Retinal fundus photograph, 1380 by 1382 pixels
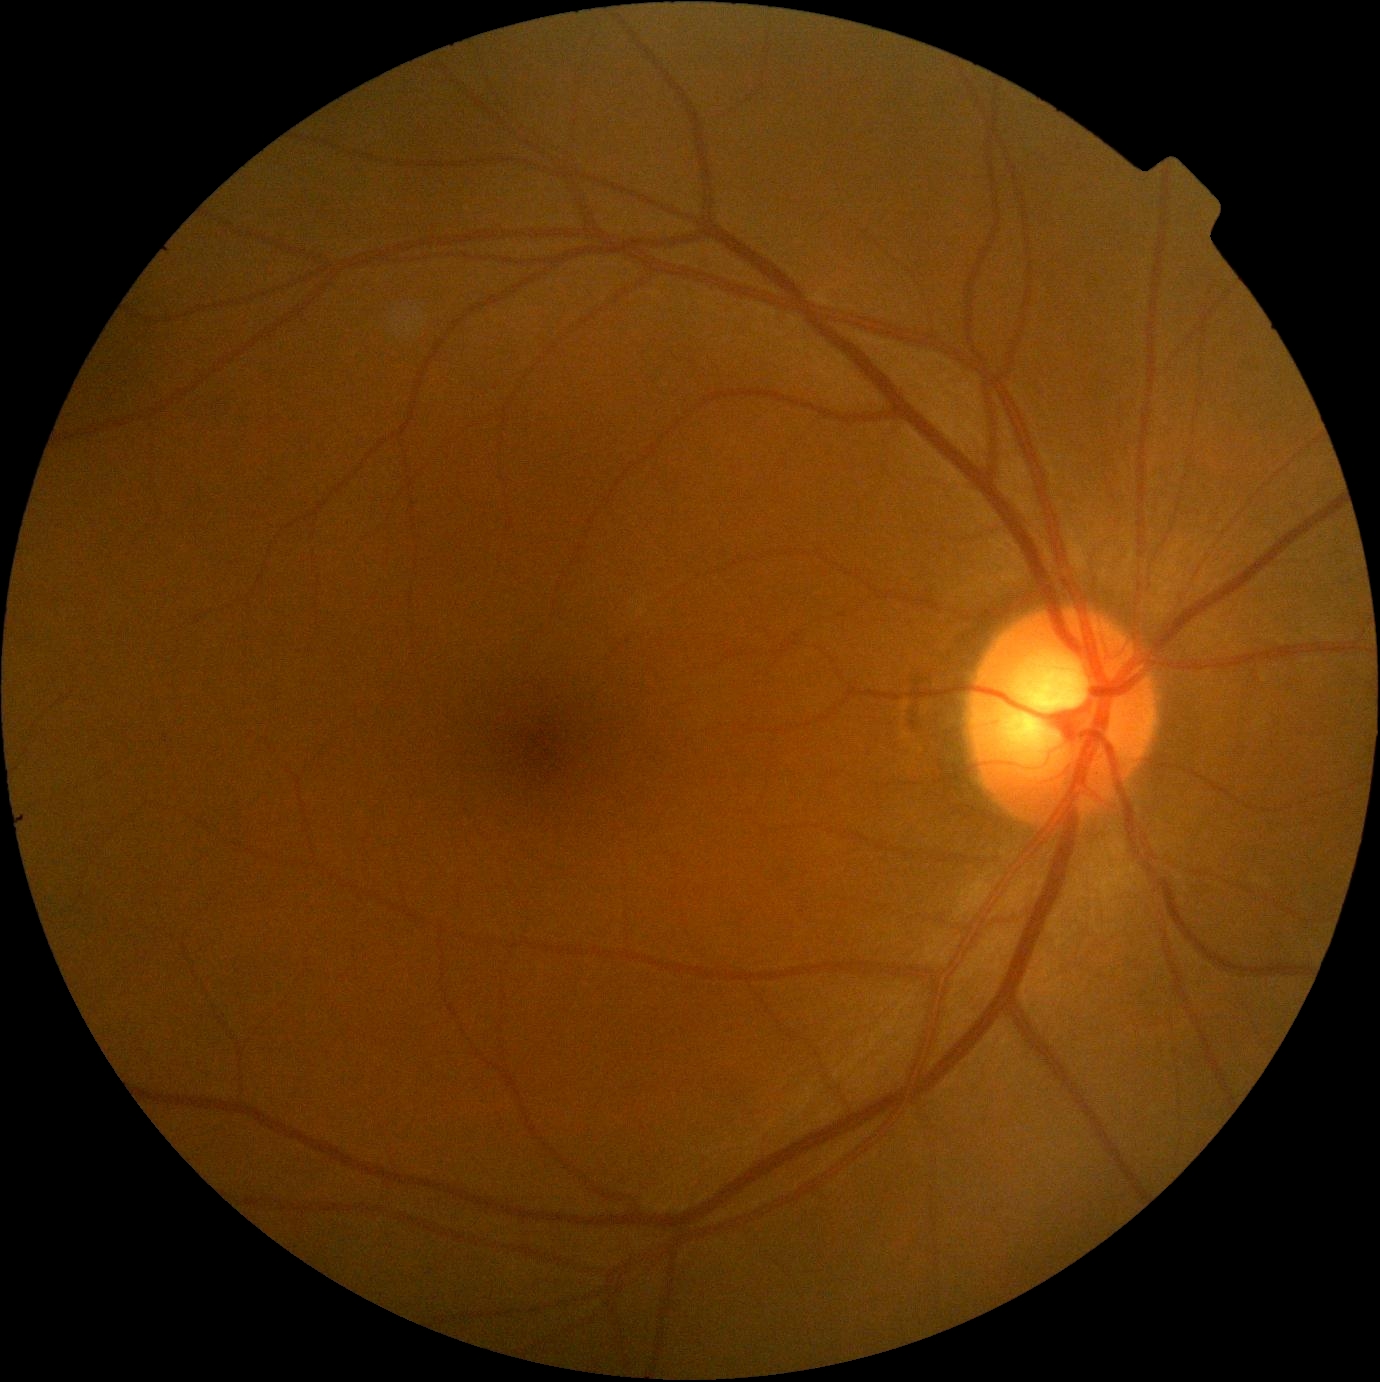 Diabetic retinopathy (DR): 0/4. No signs of diabetic retinopathy.